Without pupil dilation, color fundus photograph: 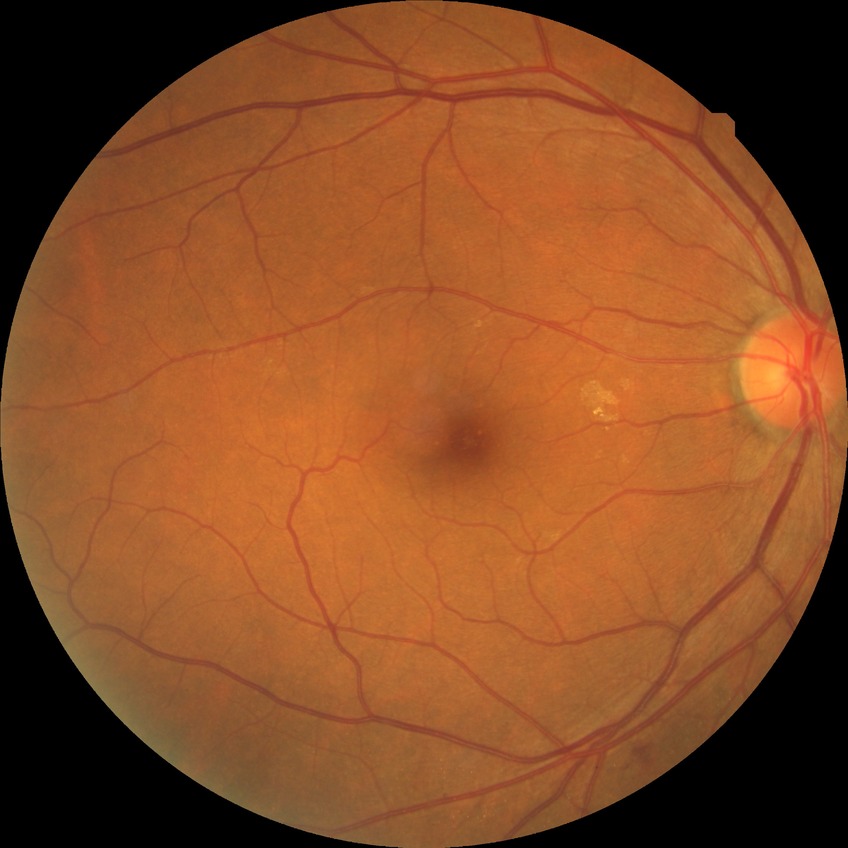

Diabetic retinopathy severity: no diabetic retinopathy.